Wide-field fundus photograph from neonatal ROP screening — 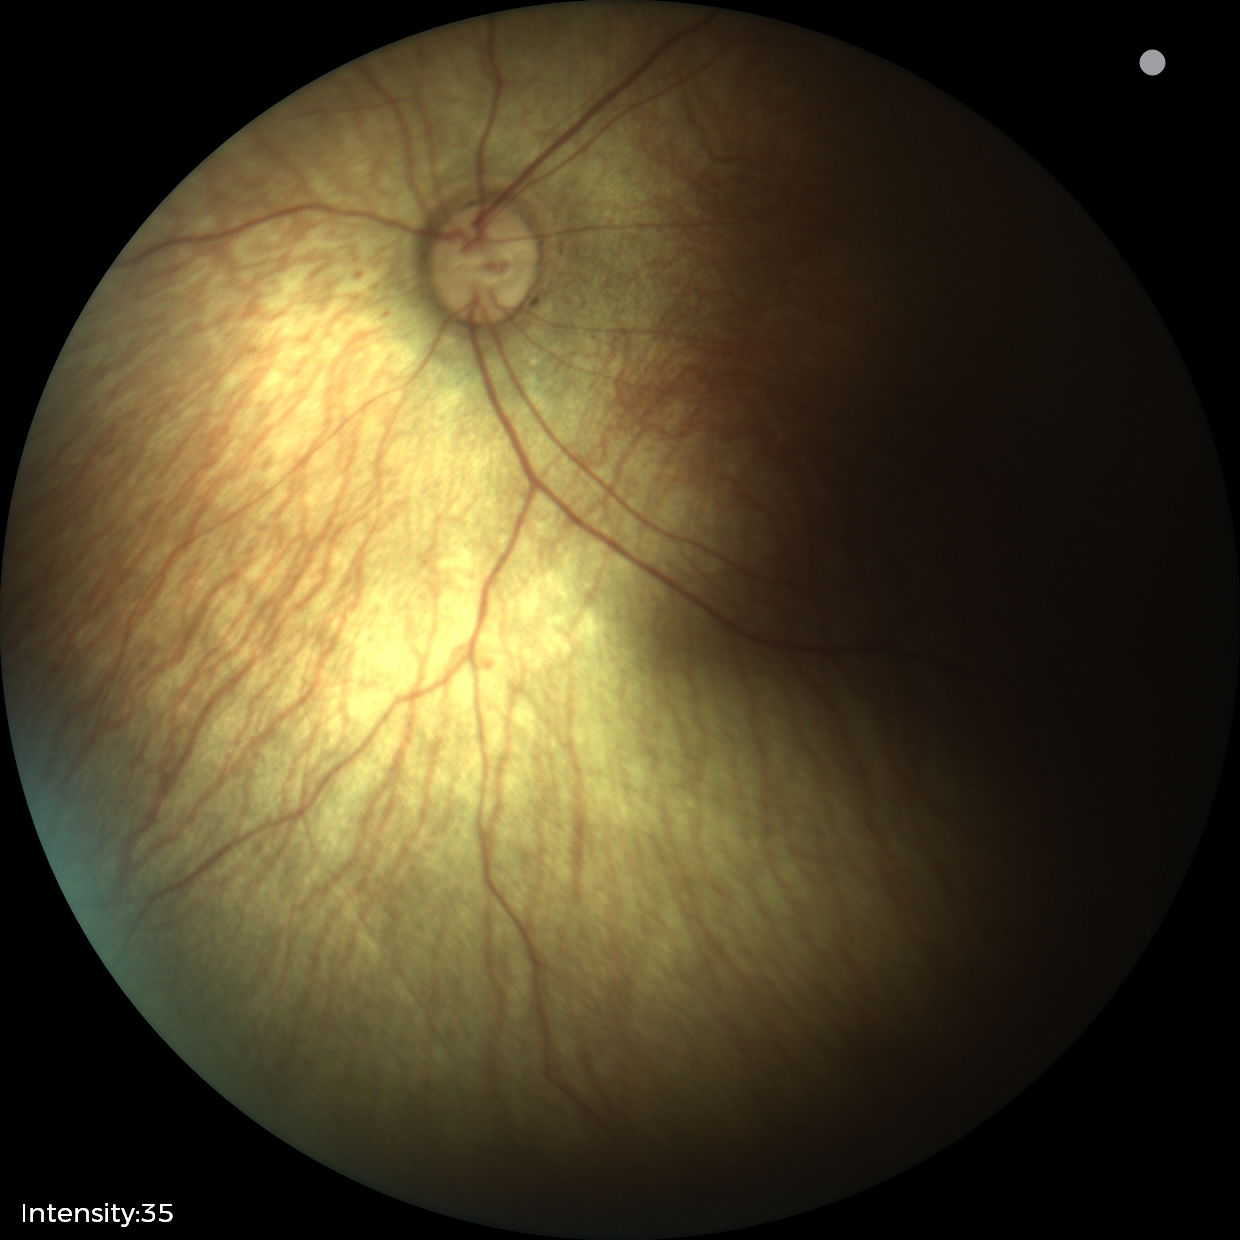 Normal screening examination.